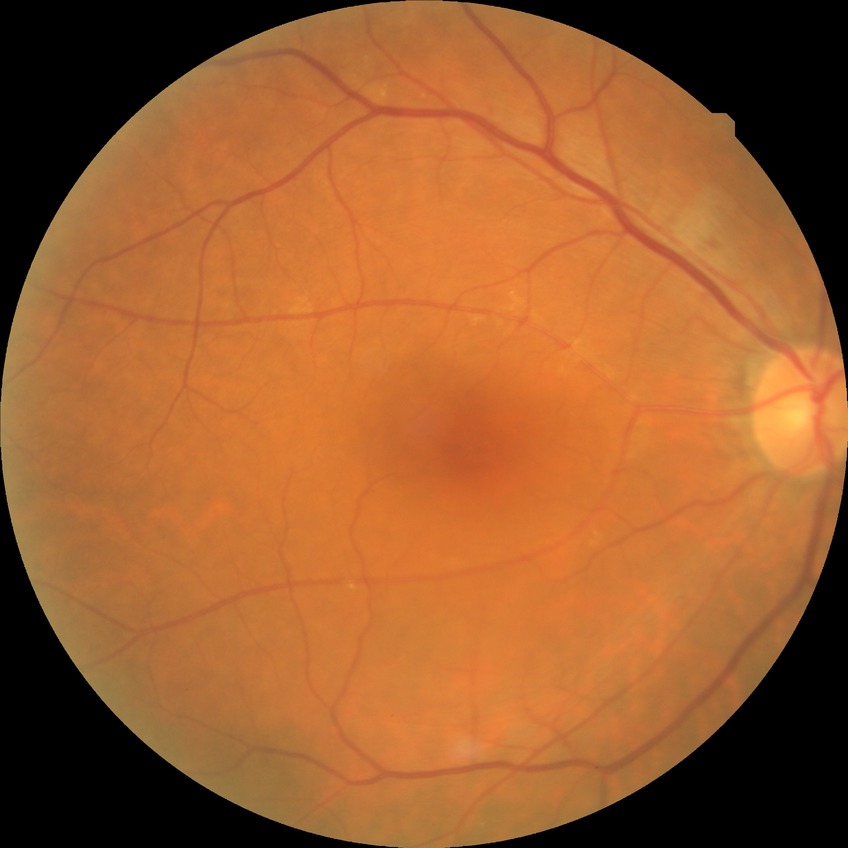 Diabetic retinopathy (DR): simple diabetic retinopathy (SDR).